50° field of view. 2228 by 1652 pixels. Pupil-dilated. Camera: Topcon TRC-50DX. Color fundus photograph:
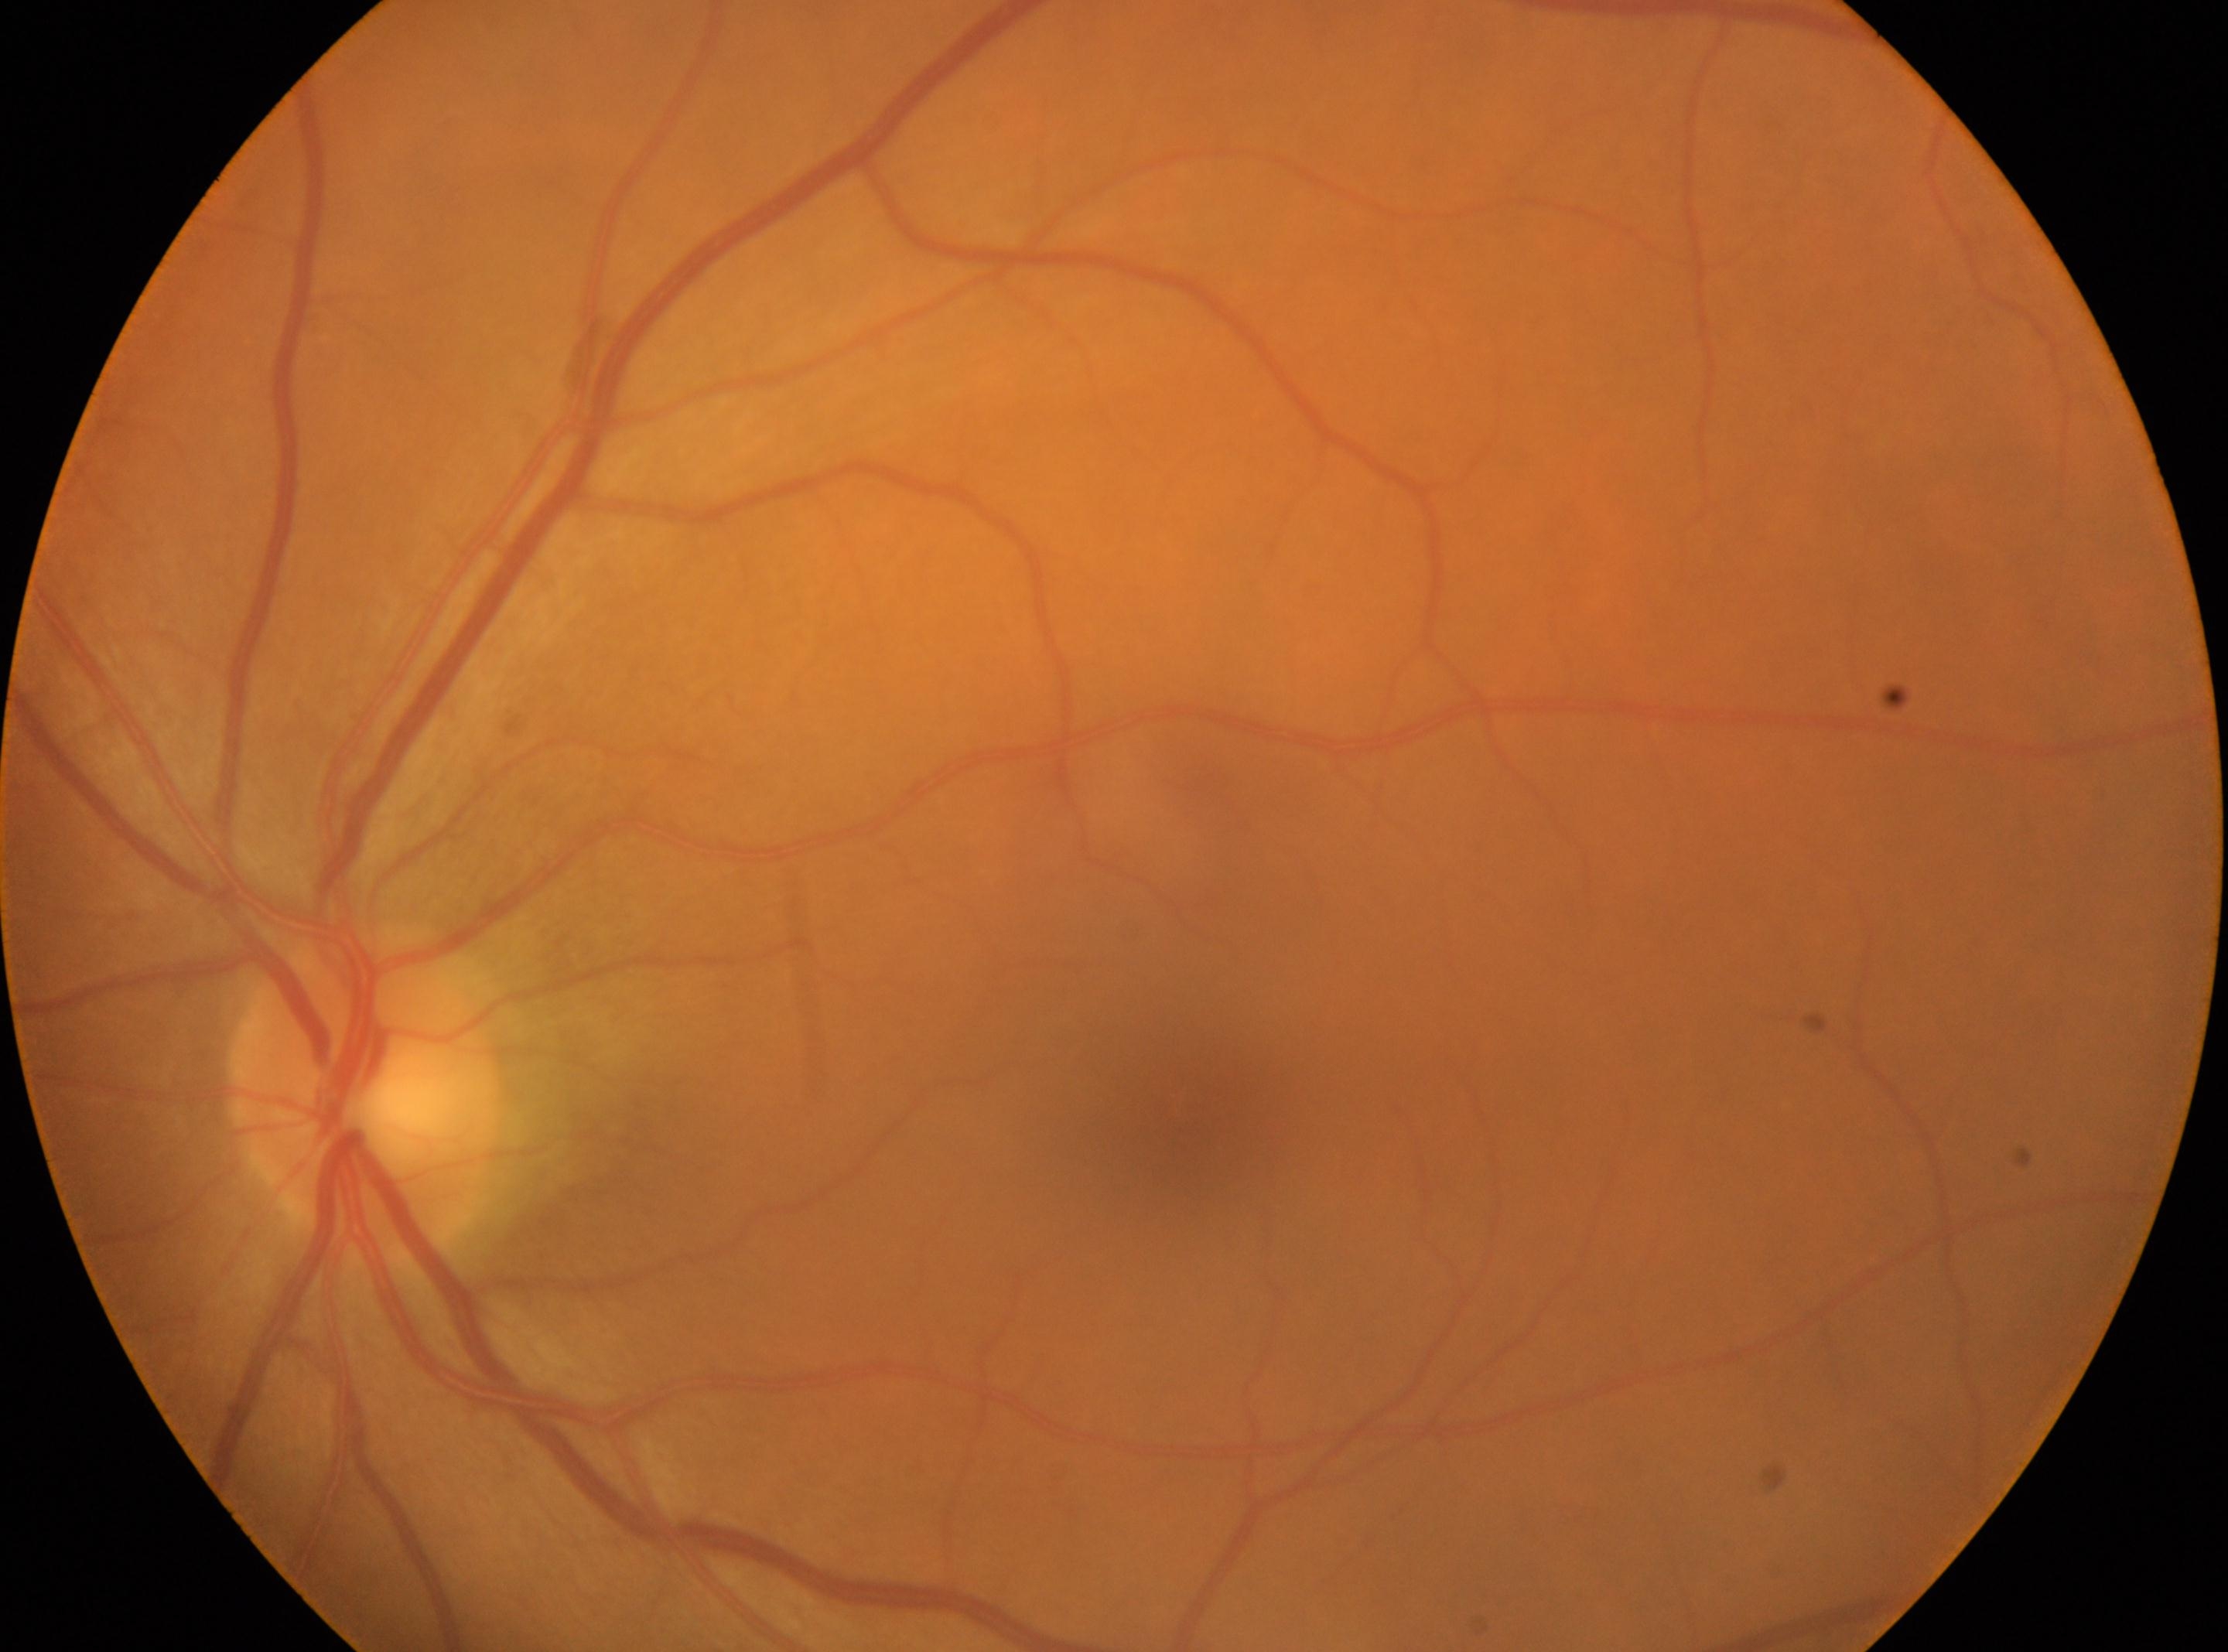

DR@0 | optic disc center@368px, 1096px | macular center@1179px, 1103px | left eye.